Nonmydriatic — 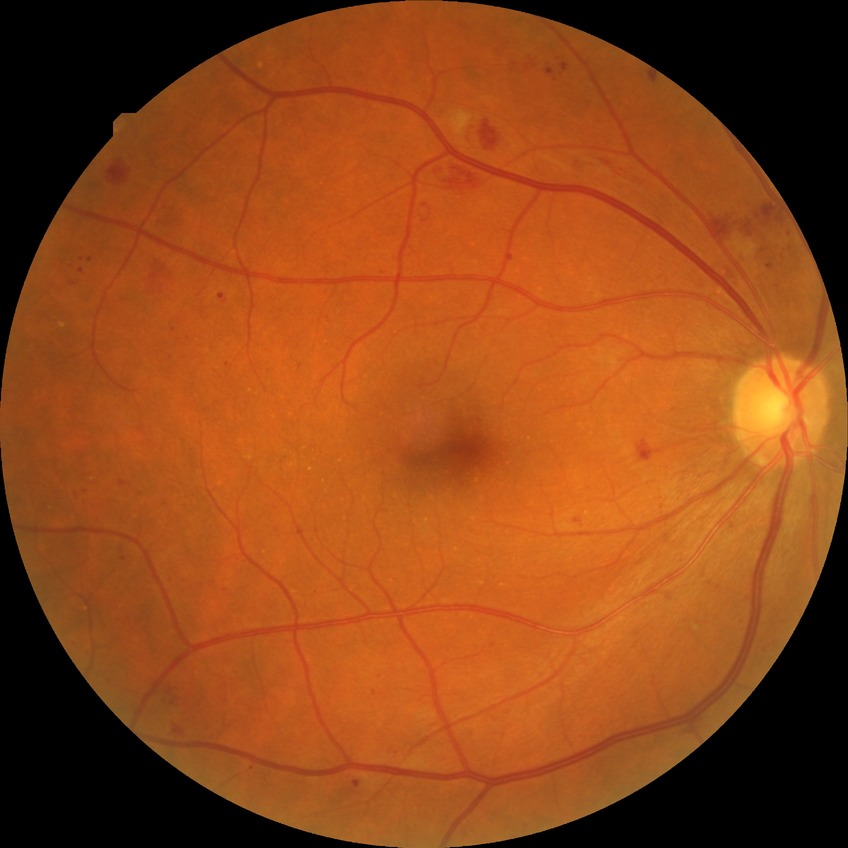 Findings:
– DR class — non-proliferative diabetic retinopathy
– diabetic retinopathy (DR) — PPDR (pre-proliferative diabetic retinopathy)